FOV: 45 degrees: 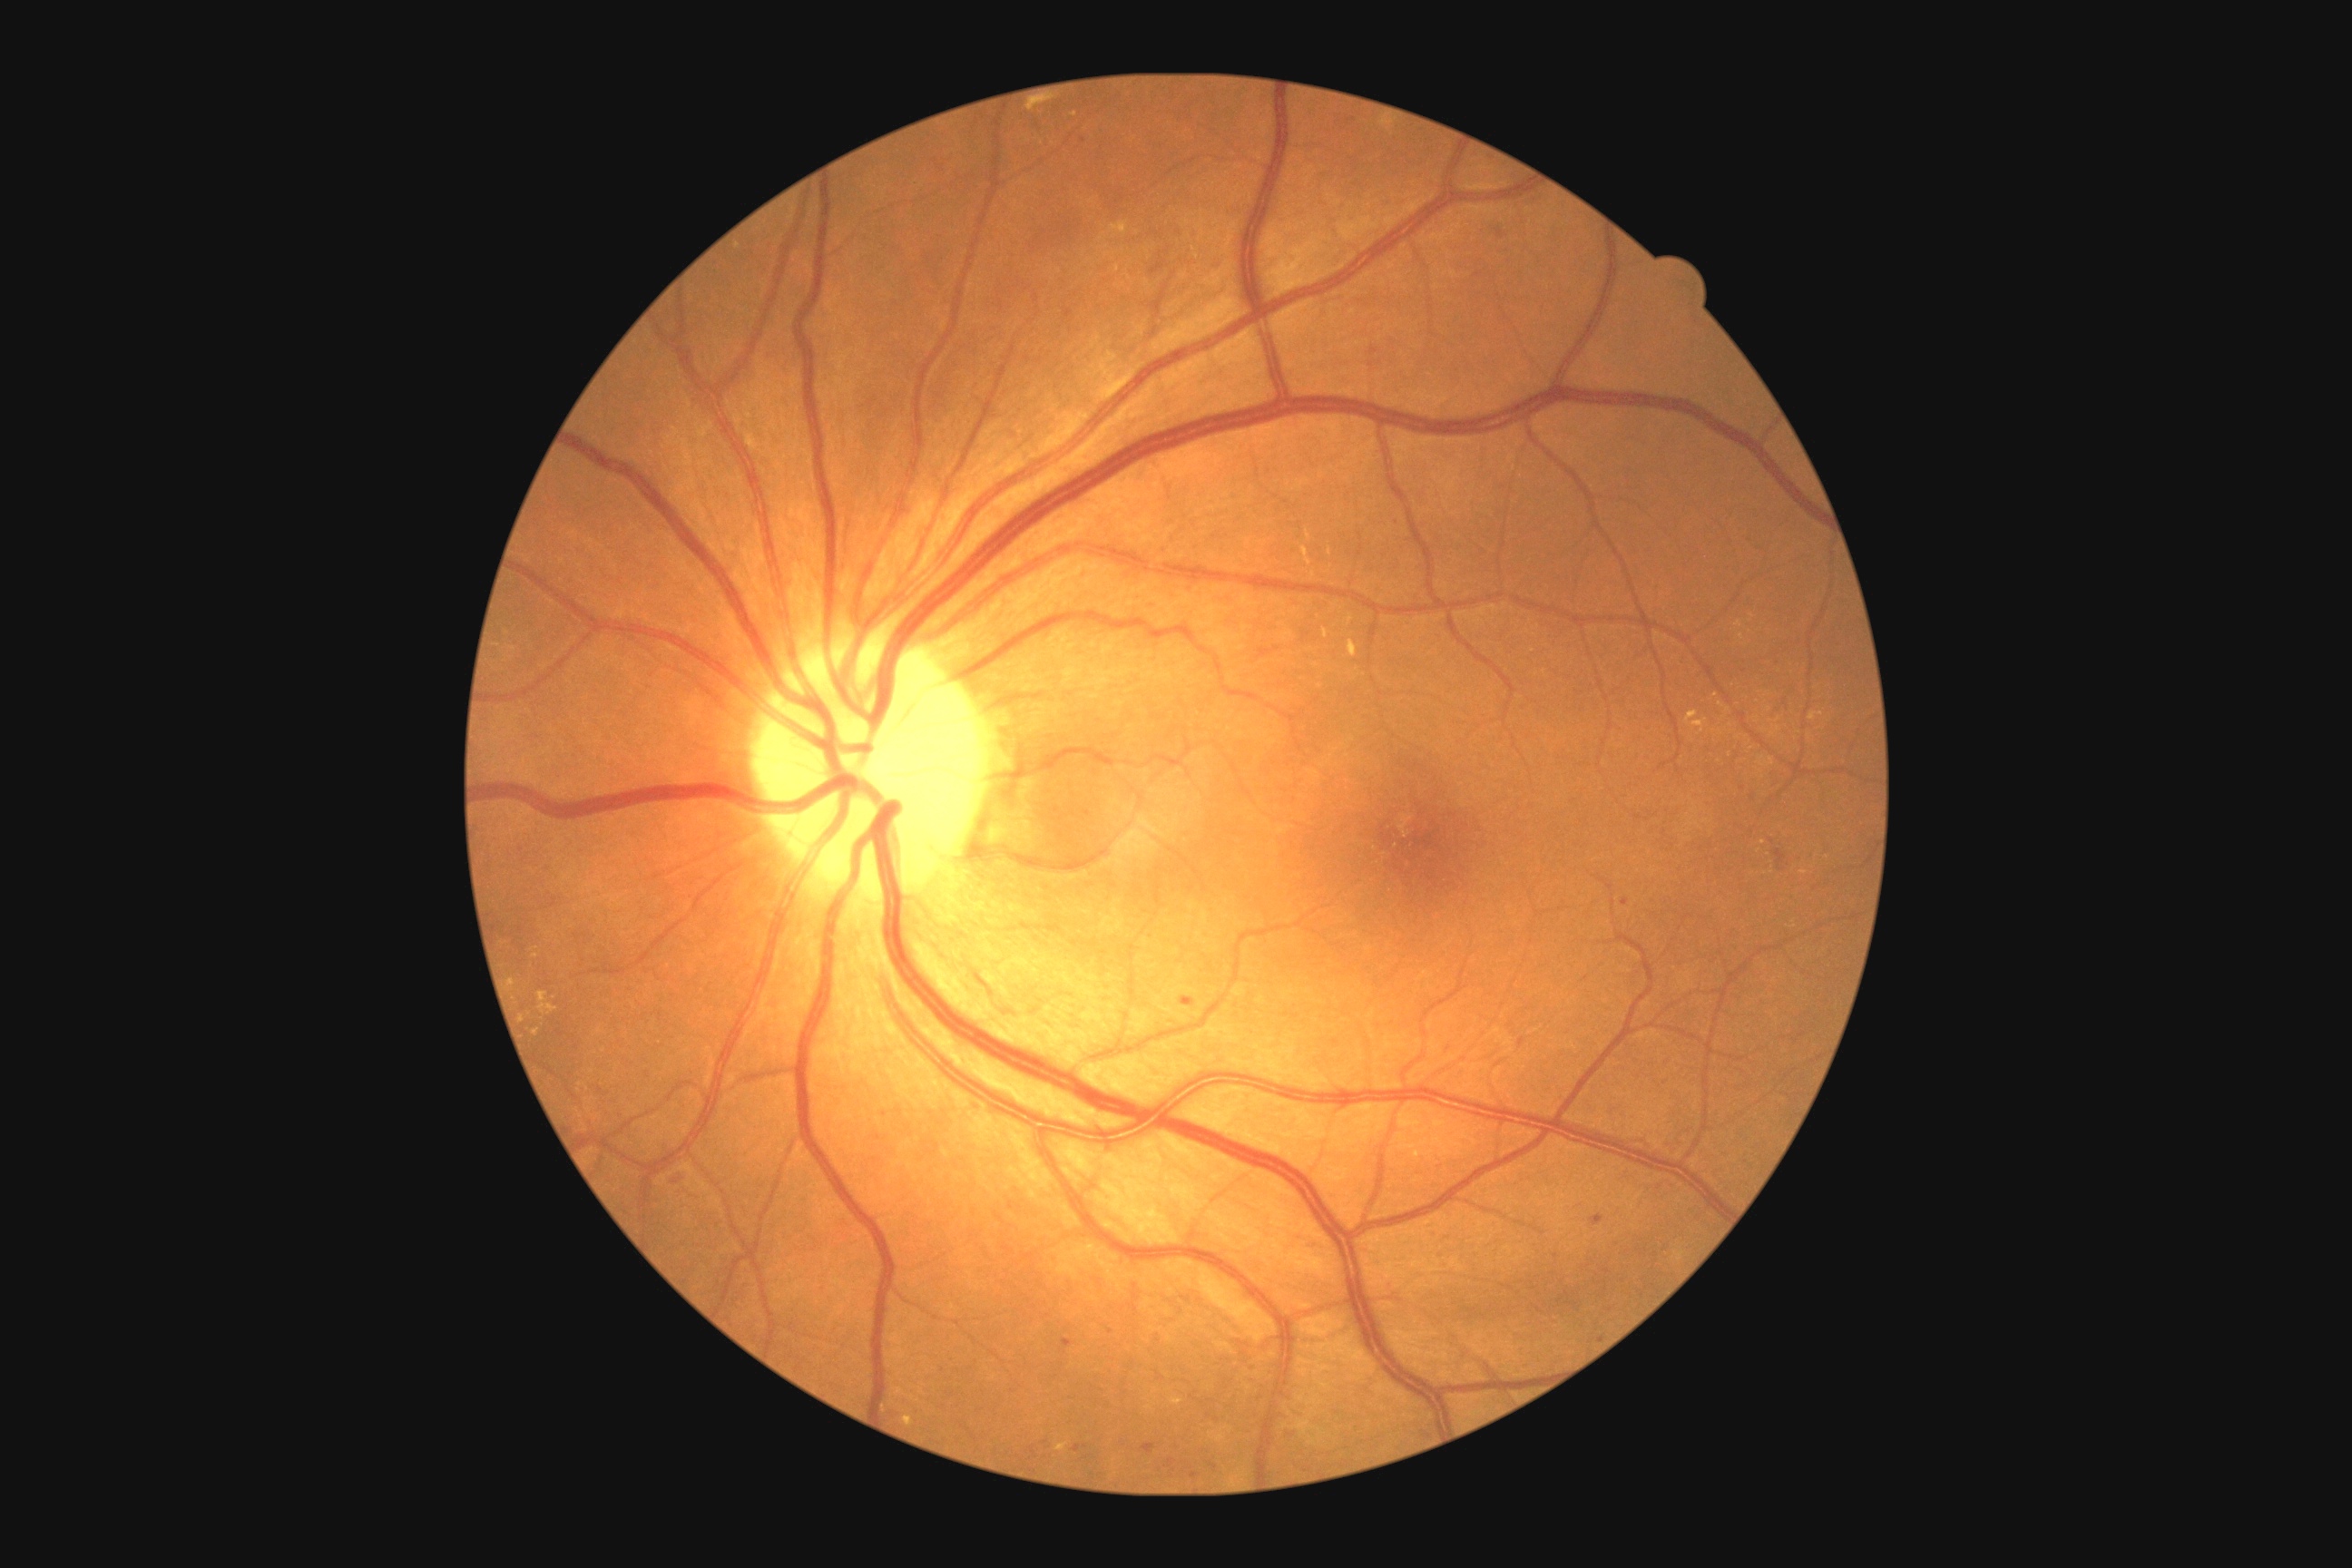 <lesions partial="true">
  <dr_grade>2</dr_grade>
  <ma partial="true"><box>1772,658,1783,669</box> | <box>1774,848,1787,872</box> | <box>1190,1473,1200,1480</box> | <box>1622,899,1631,906</box> | <box>1142,1444,1157,1453</box> | <box>1064,309,1073,318</box> | <box>1391,518,1404,527</box></ma>
  <ma_small_centers>[x=1785, y=702] | [x=1449, y=1050] | [x=1083, y=139] | [x=1111, y=1332]</ma_small_centers>
  <ex partial="true"><box>1171,1398,1182,1406</box> | <box>1349,614,1355,625</box> | <box>1349,640,1357,658</box> | <box>538,992,558,1015</box> | <box>903,1416,914,1427</box> | <box>533,1028,540,1037</box> | <box>1110,222,1128,235</box></ex>
  <ex_small_centers>[x=1763, y=843] | [x=1739, y=624] | [x=1716, y=695] | [x=512, y=983] | [x=1076, y=115] | [x=1742, y=637] | [x=689, y=1052] | [x=1417, y=1156] | [x=1804, y=874]</ex_small_centers>
</lesions>